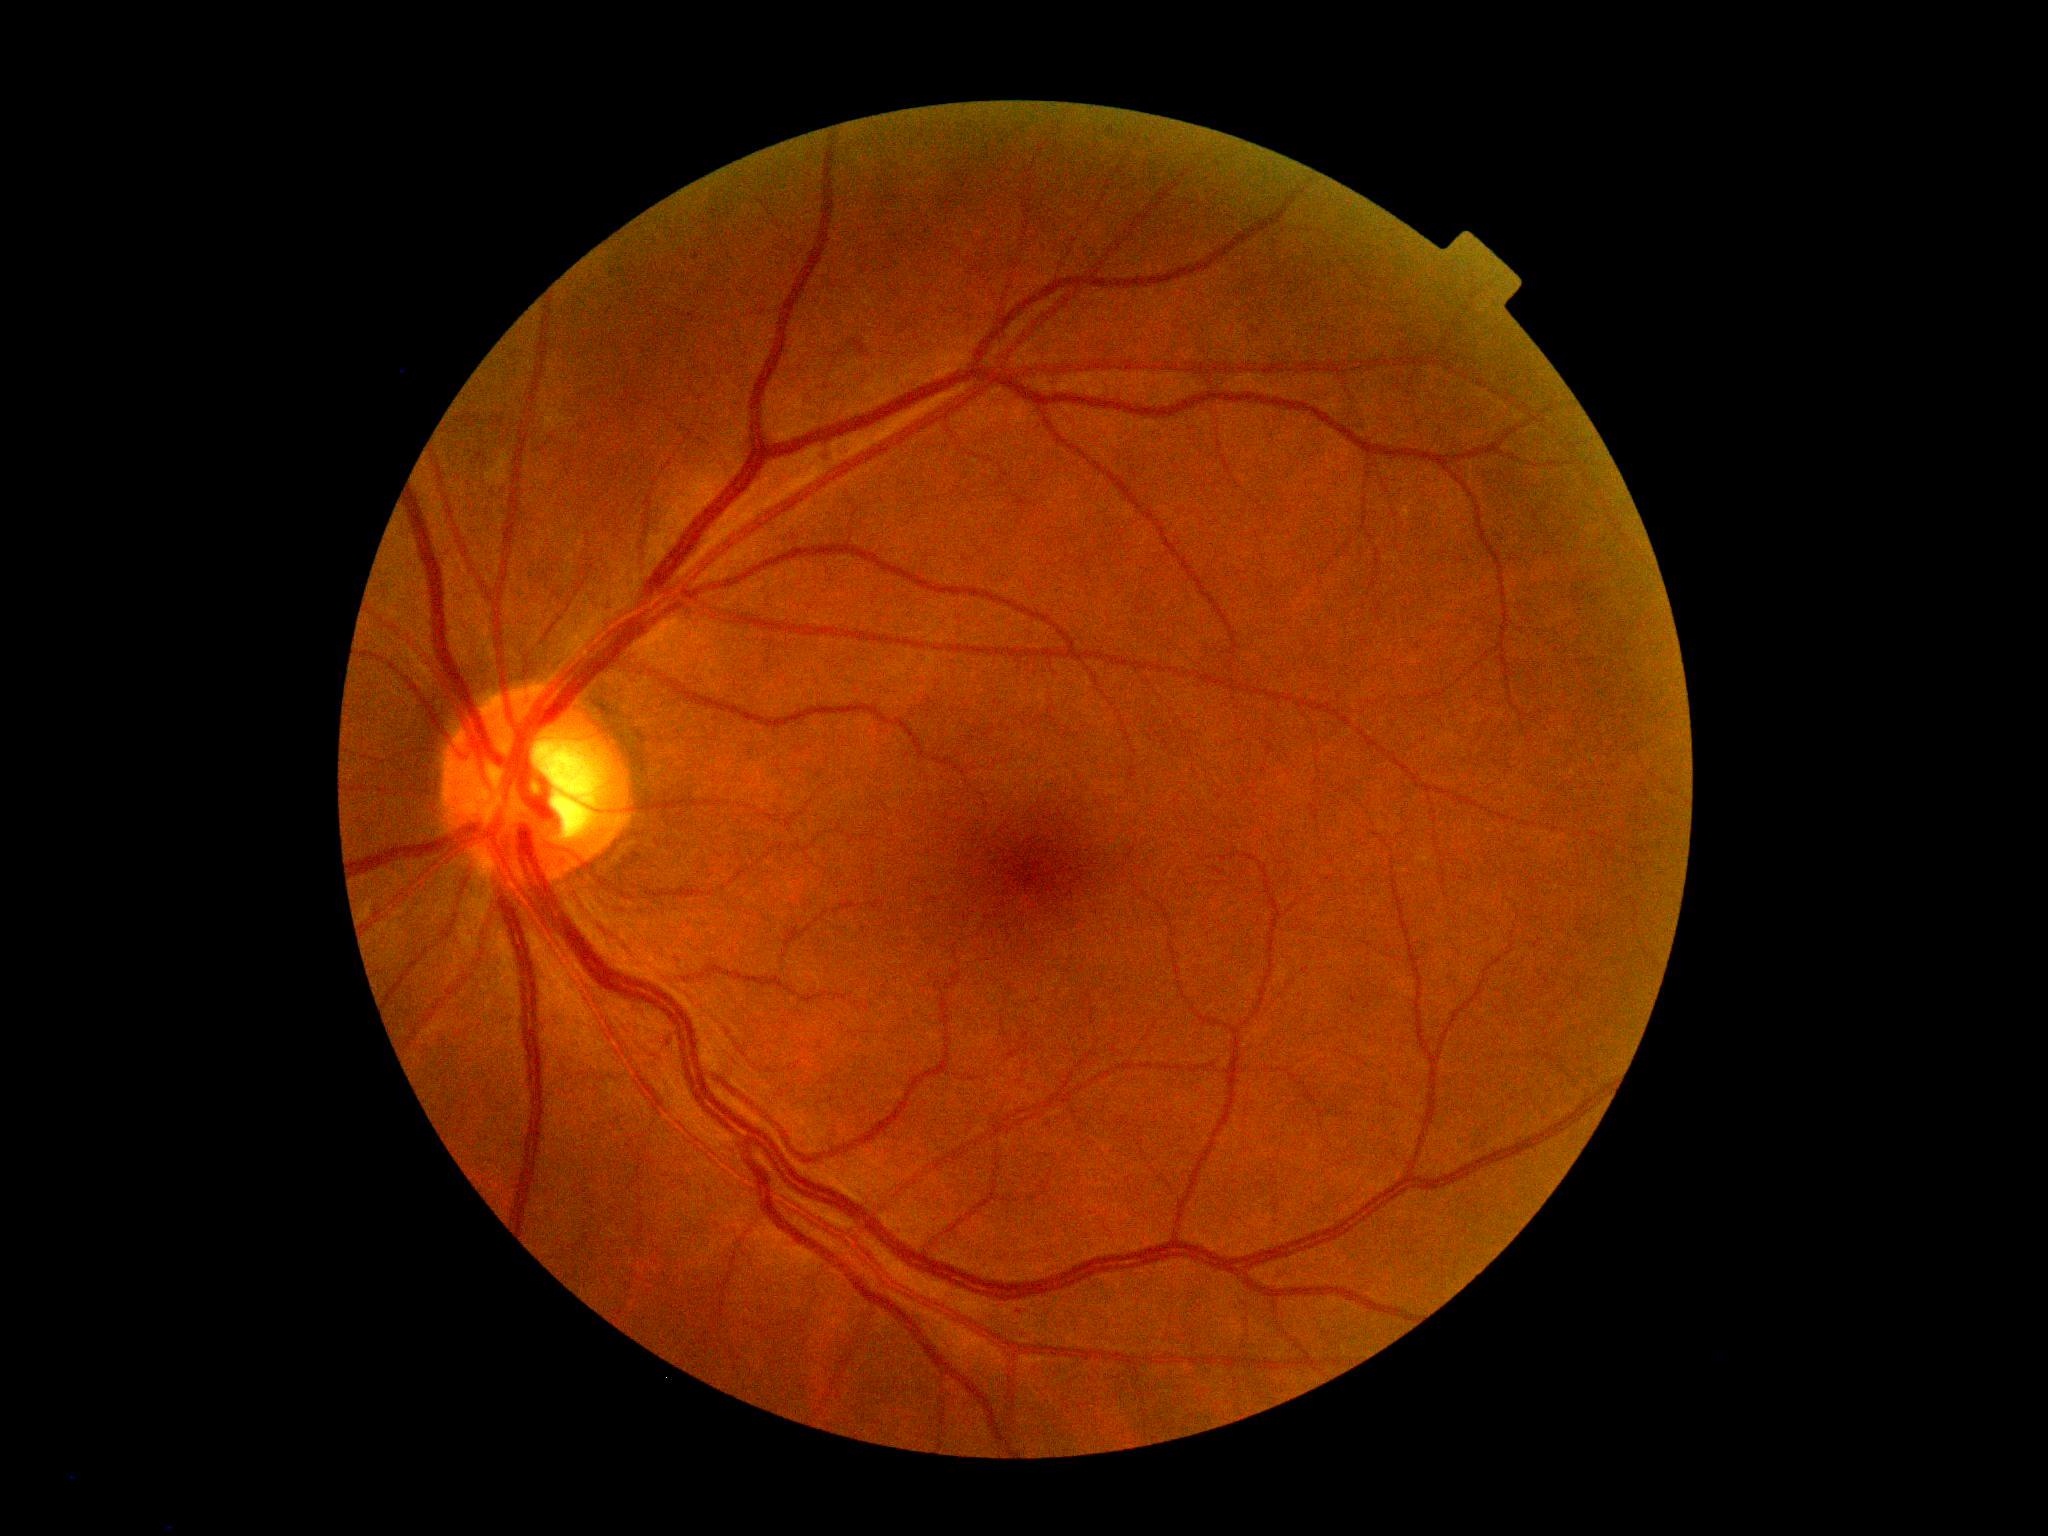

Disease class: non-proliferative diabetic retinopathy.
Retinopathy: grade 2 (moderate NPDR) — more than just microaneurysms but less than severe NPDR.